848 by 848 pixels; posterior pole photograph; FOV: 45 degrees; graded on the modified Davis scale; NIDEK AFC-230: 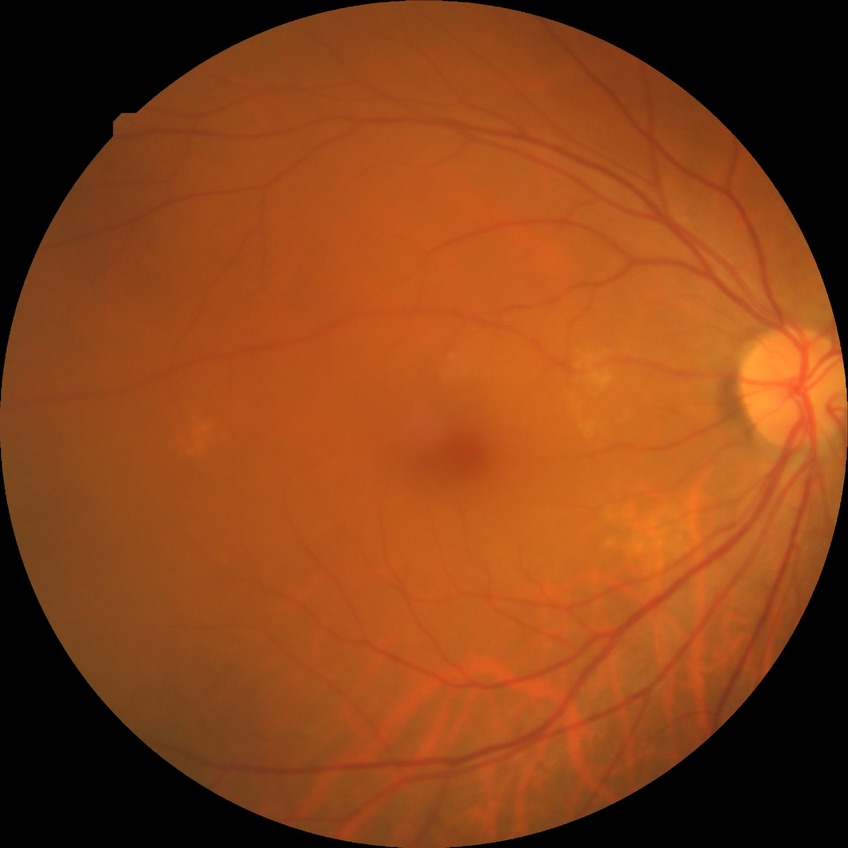
Diabetic retinopathy (DR): no diabetic retinopathy (NDR).